Retinal fundus photograph.
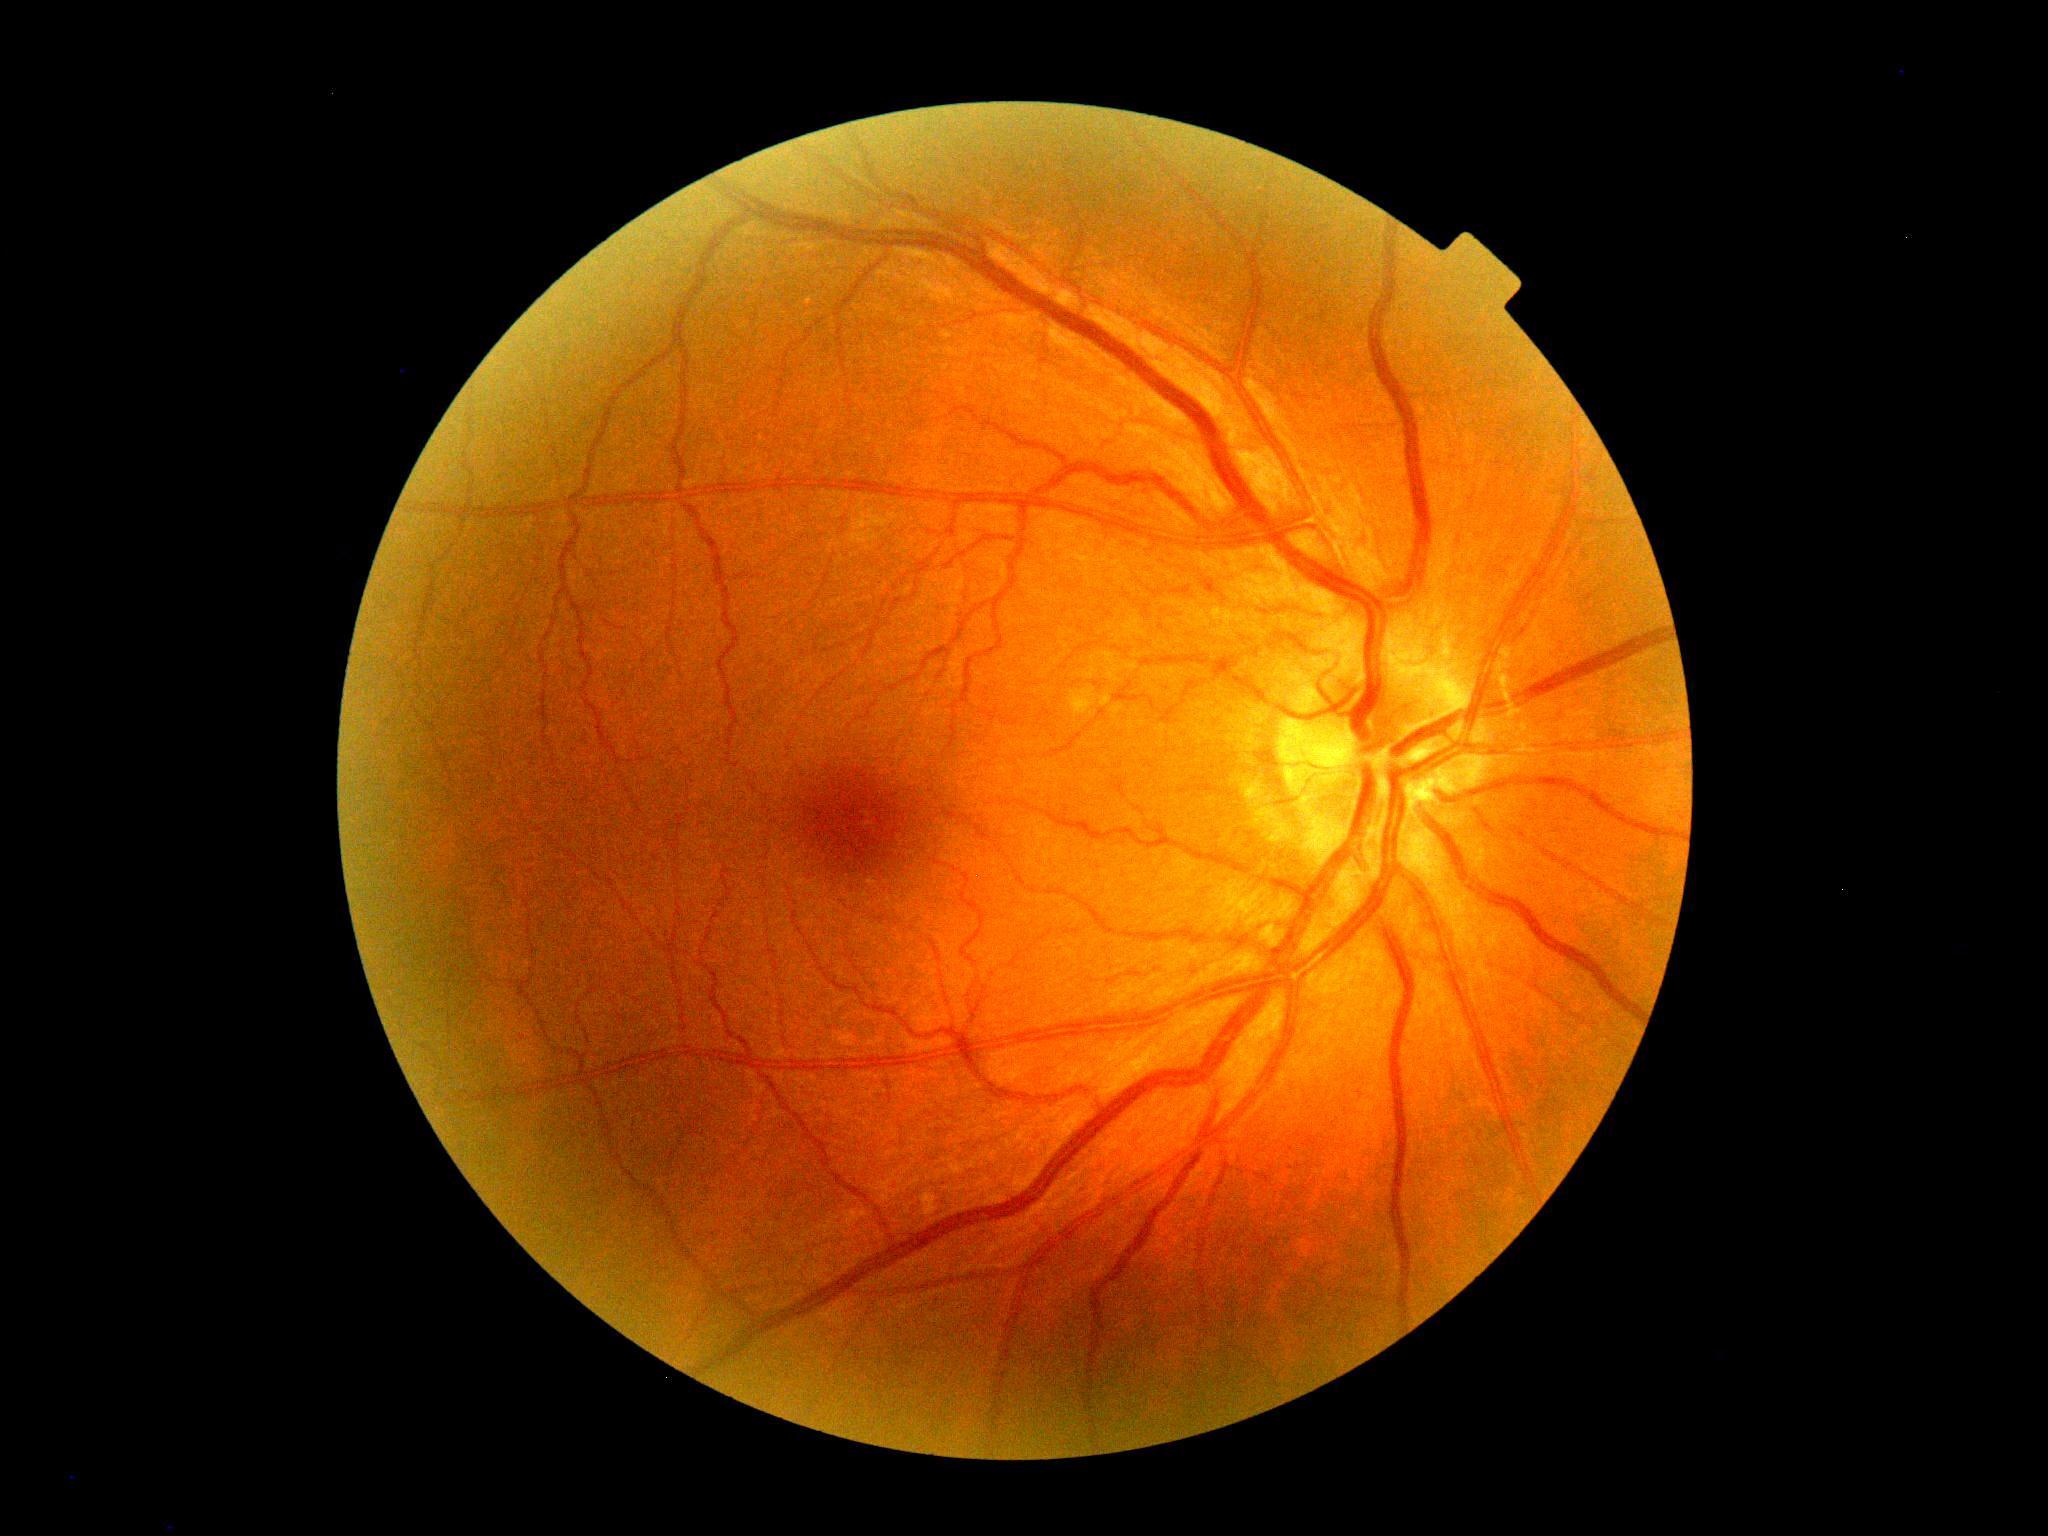
DR impression: no DR findings, diabetic retinopathy grade: no apparent diabetic retinopathy (0).